Modified Davis grading
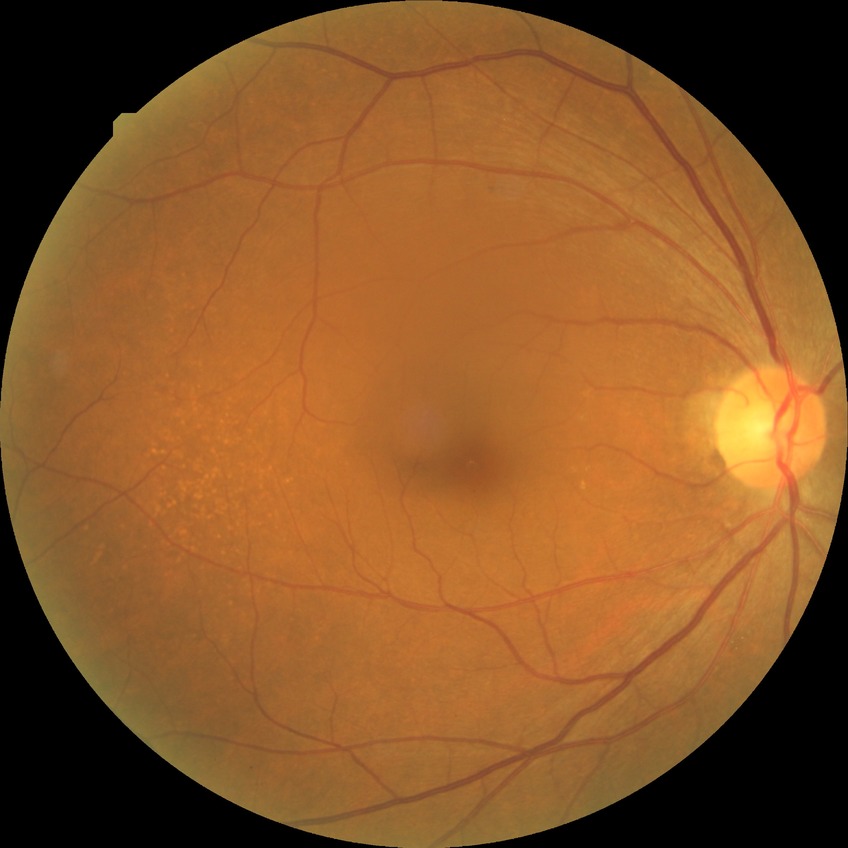 Modified Davis grading: no diabetic retinopathy.